Non-mydriatic.
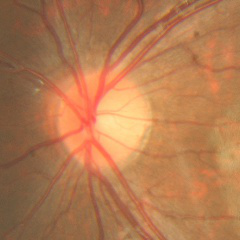 Diagnosis: no glaucomatous changes.